Acquired with a NIDEK AFC-230 · no pharmacologic dilation · graded on the modified Davis scale · 848 by 848 pixels:
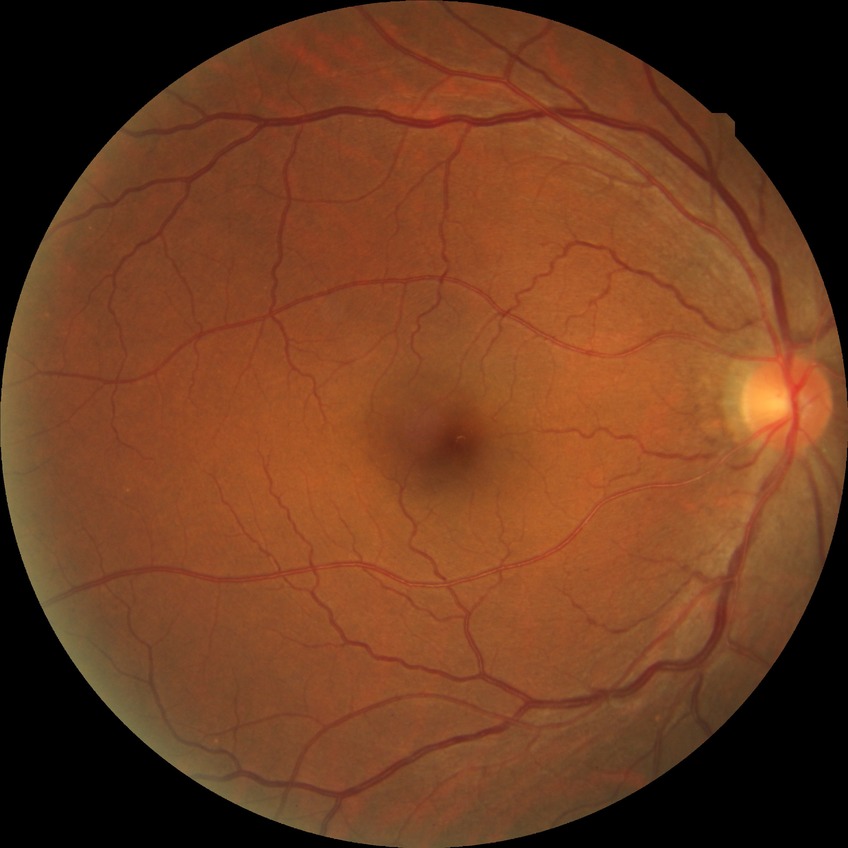

DR: NDR.